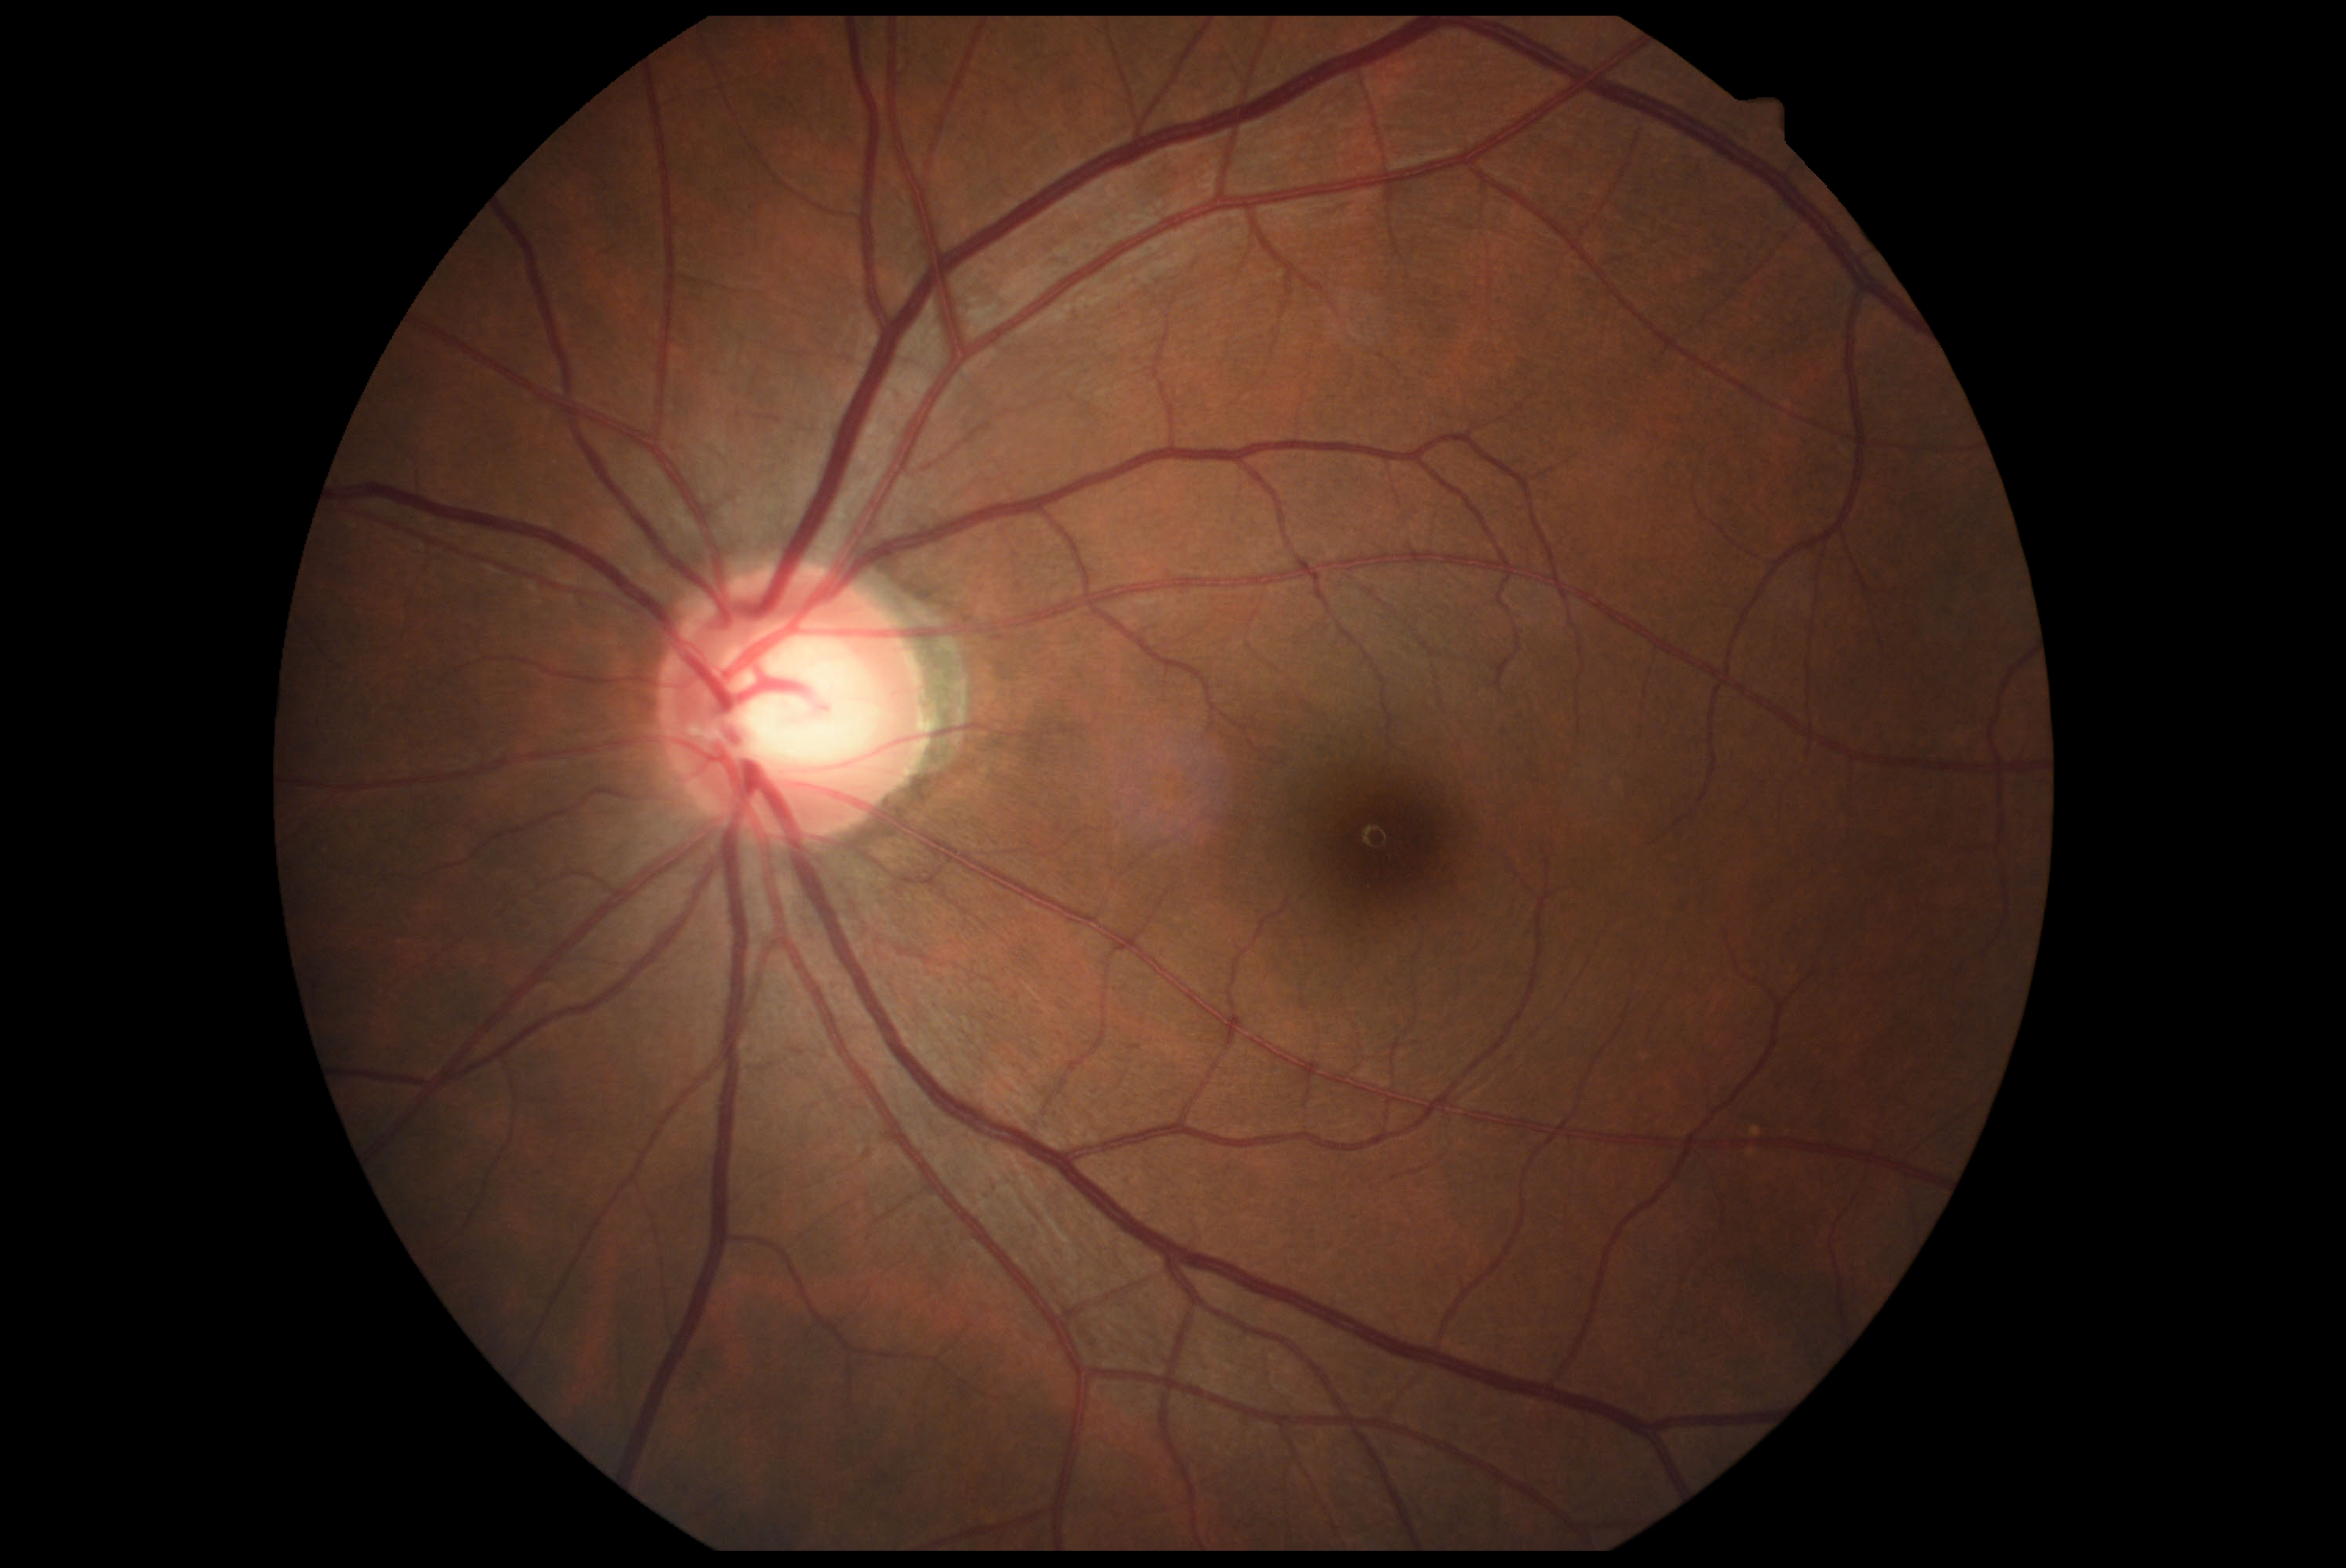 DR: no apparent diabetic retinopathy (grade 0).